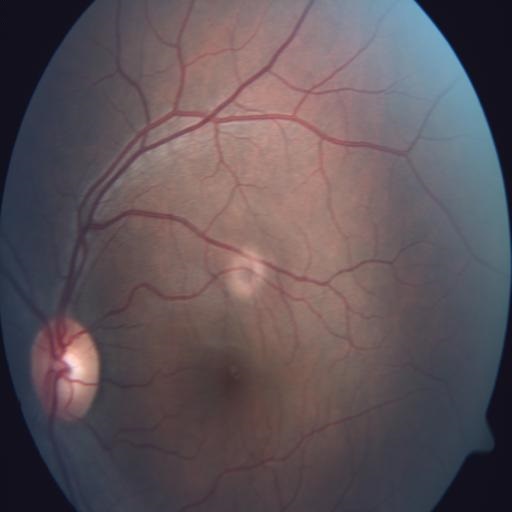 Fundus image with findings of retinal pigment epithelium changes.